Acquired on the Clarity RetCam 3; wide-field fundus photograph from neonatal ROP screening.
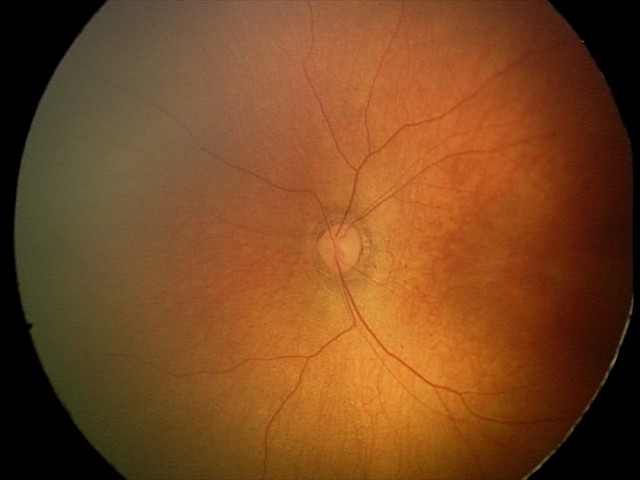

Screening examination with no abnormal retinal findings.